Nonmydriatic fundus photograph. FOV: 45 degrees. Modified Davis classification. Color fundus photograph
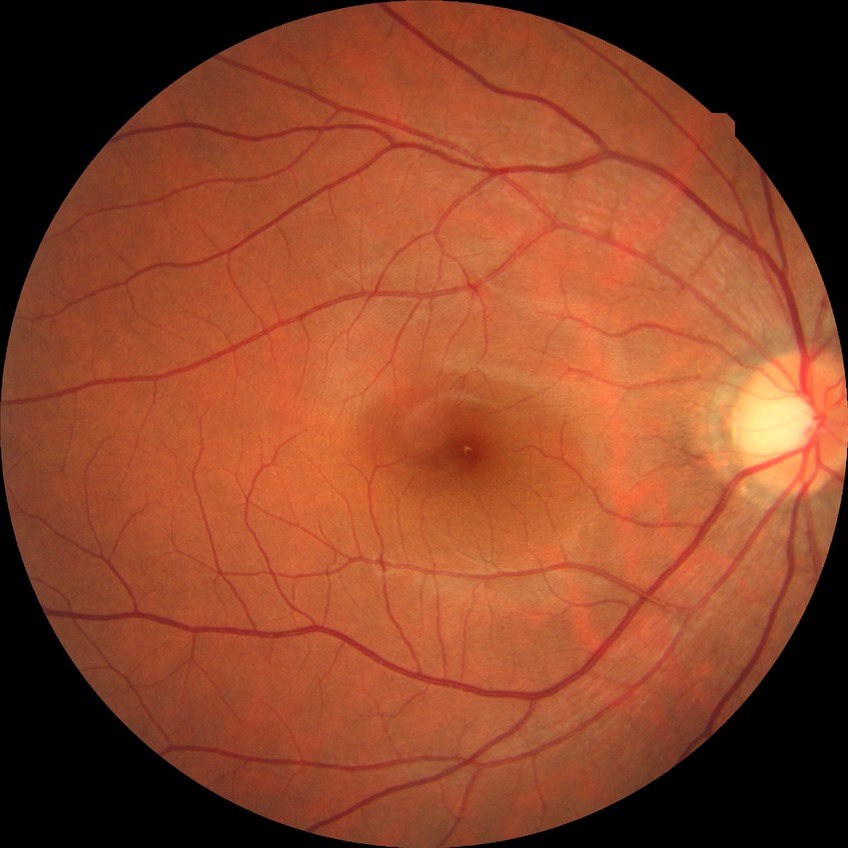

Diabetic retinopathy (DR): NDR (no diabetic retinopathy).